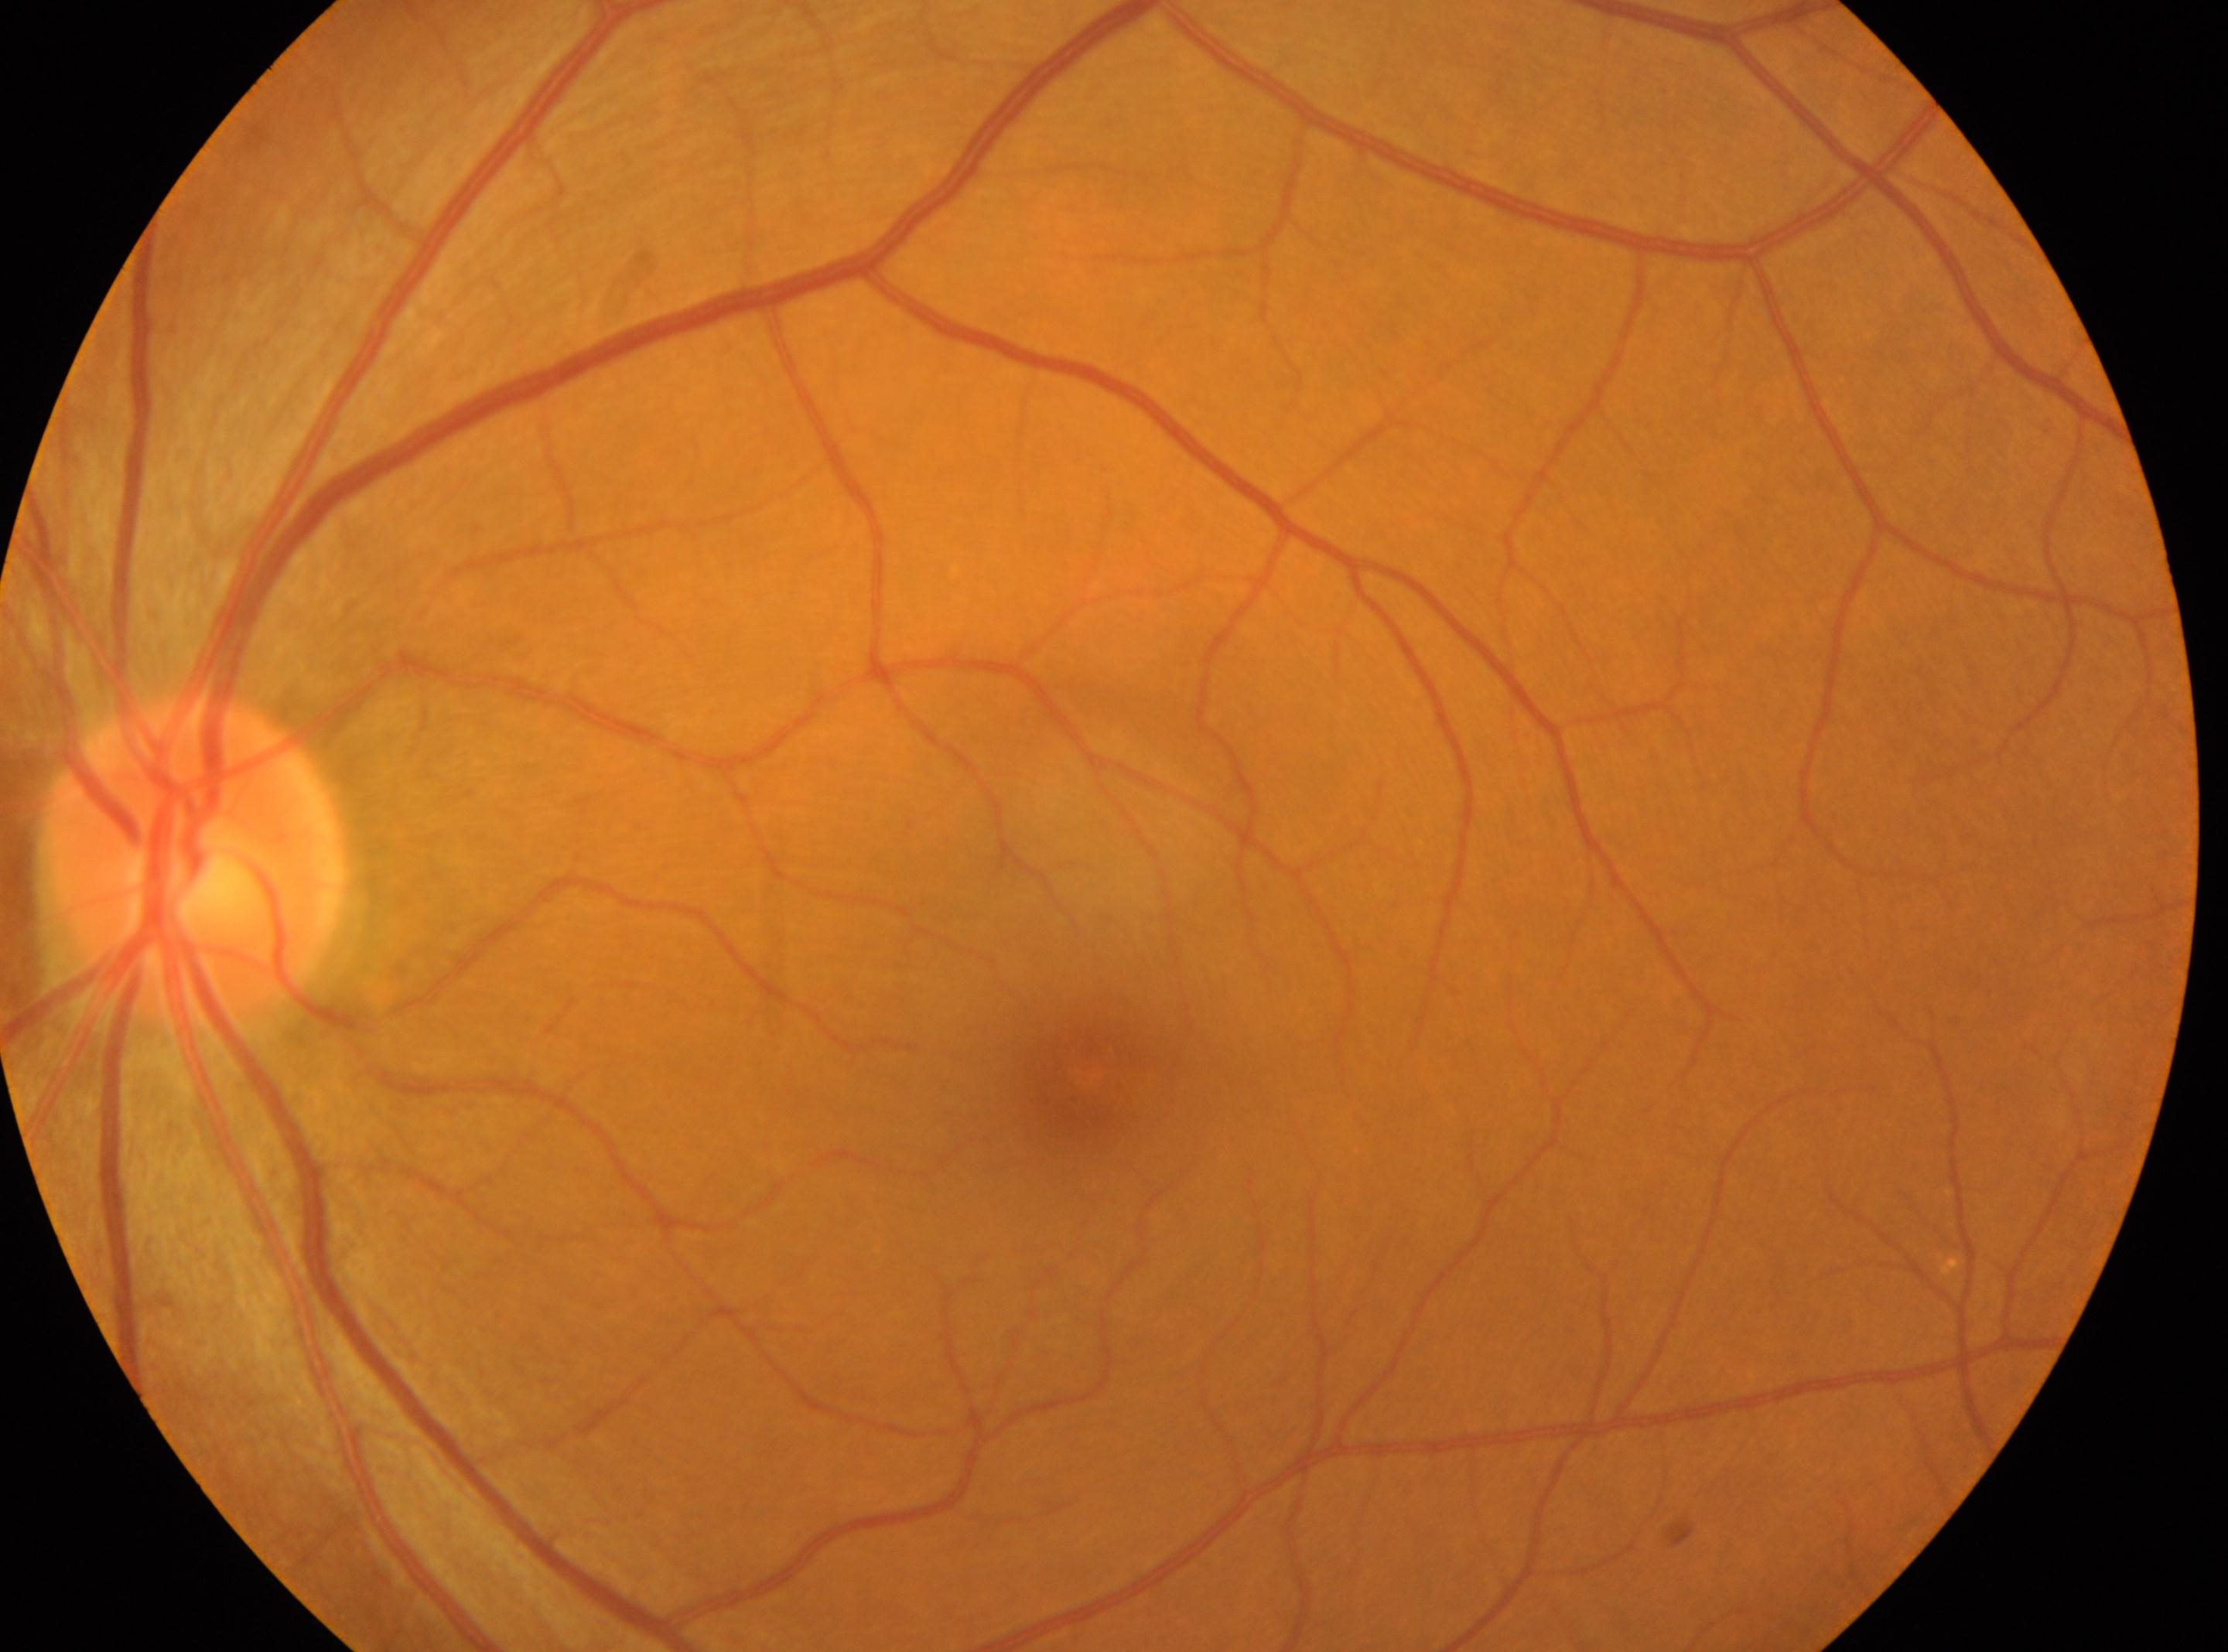
Diabetic retinopathy (DR): 0. Imaged eye: the left eye. Fovea center located at 1085px, 1077px. Optic disc located at 193px, 858px.